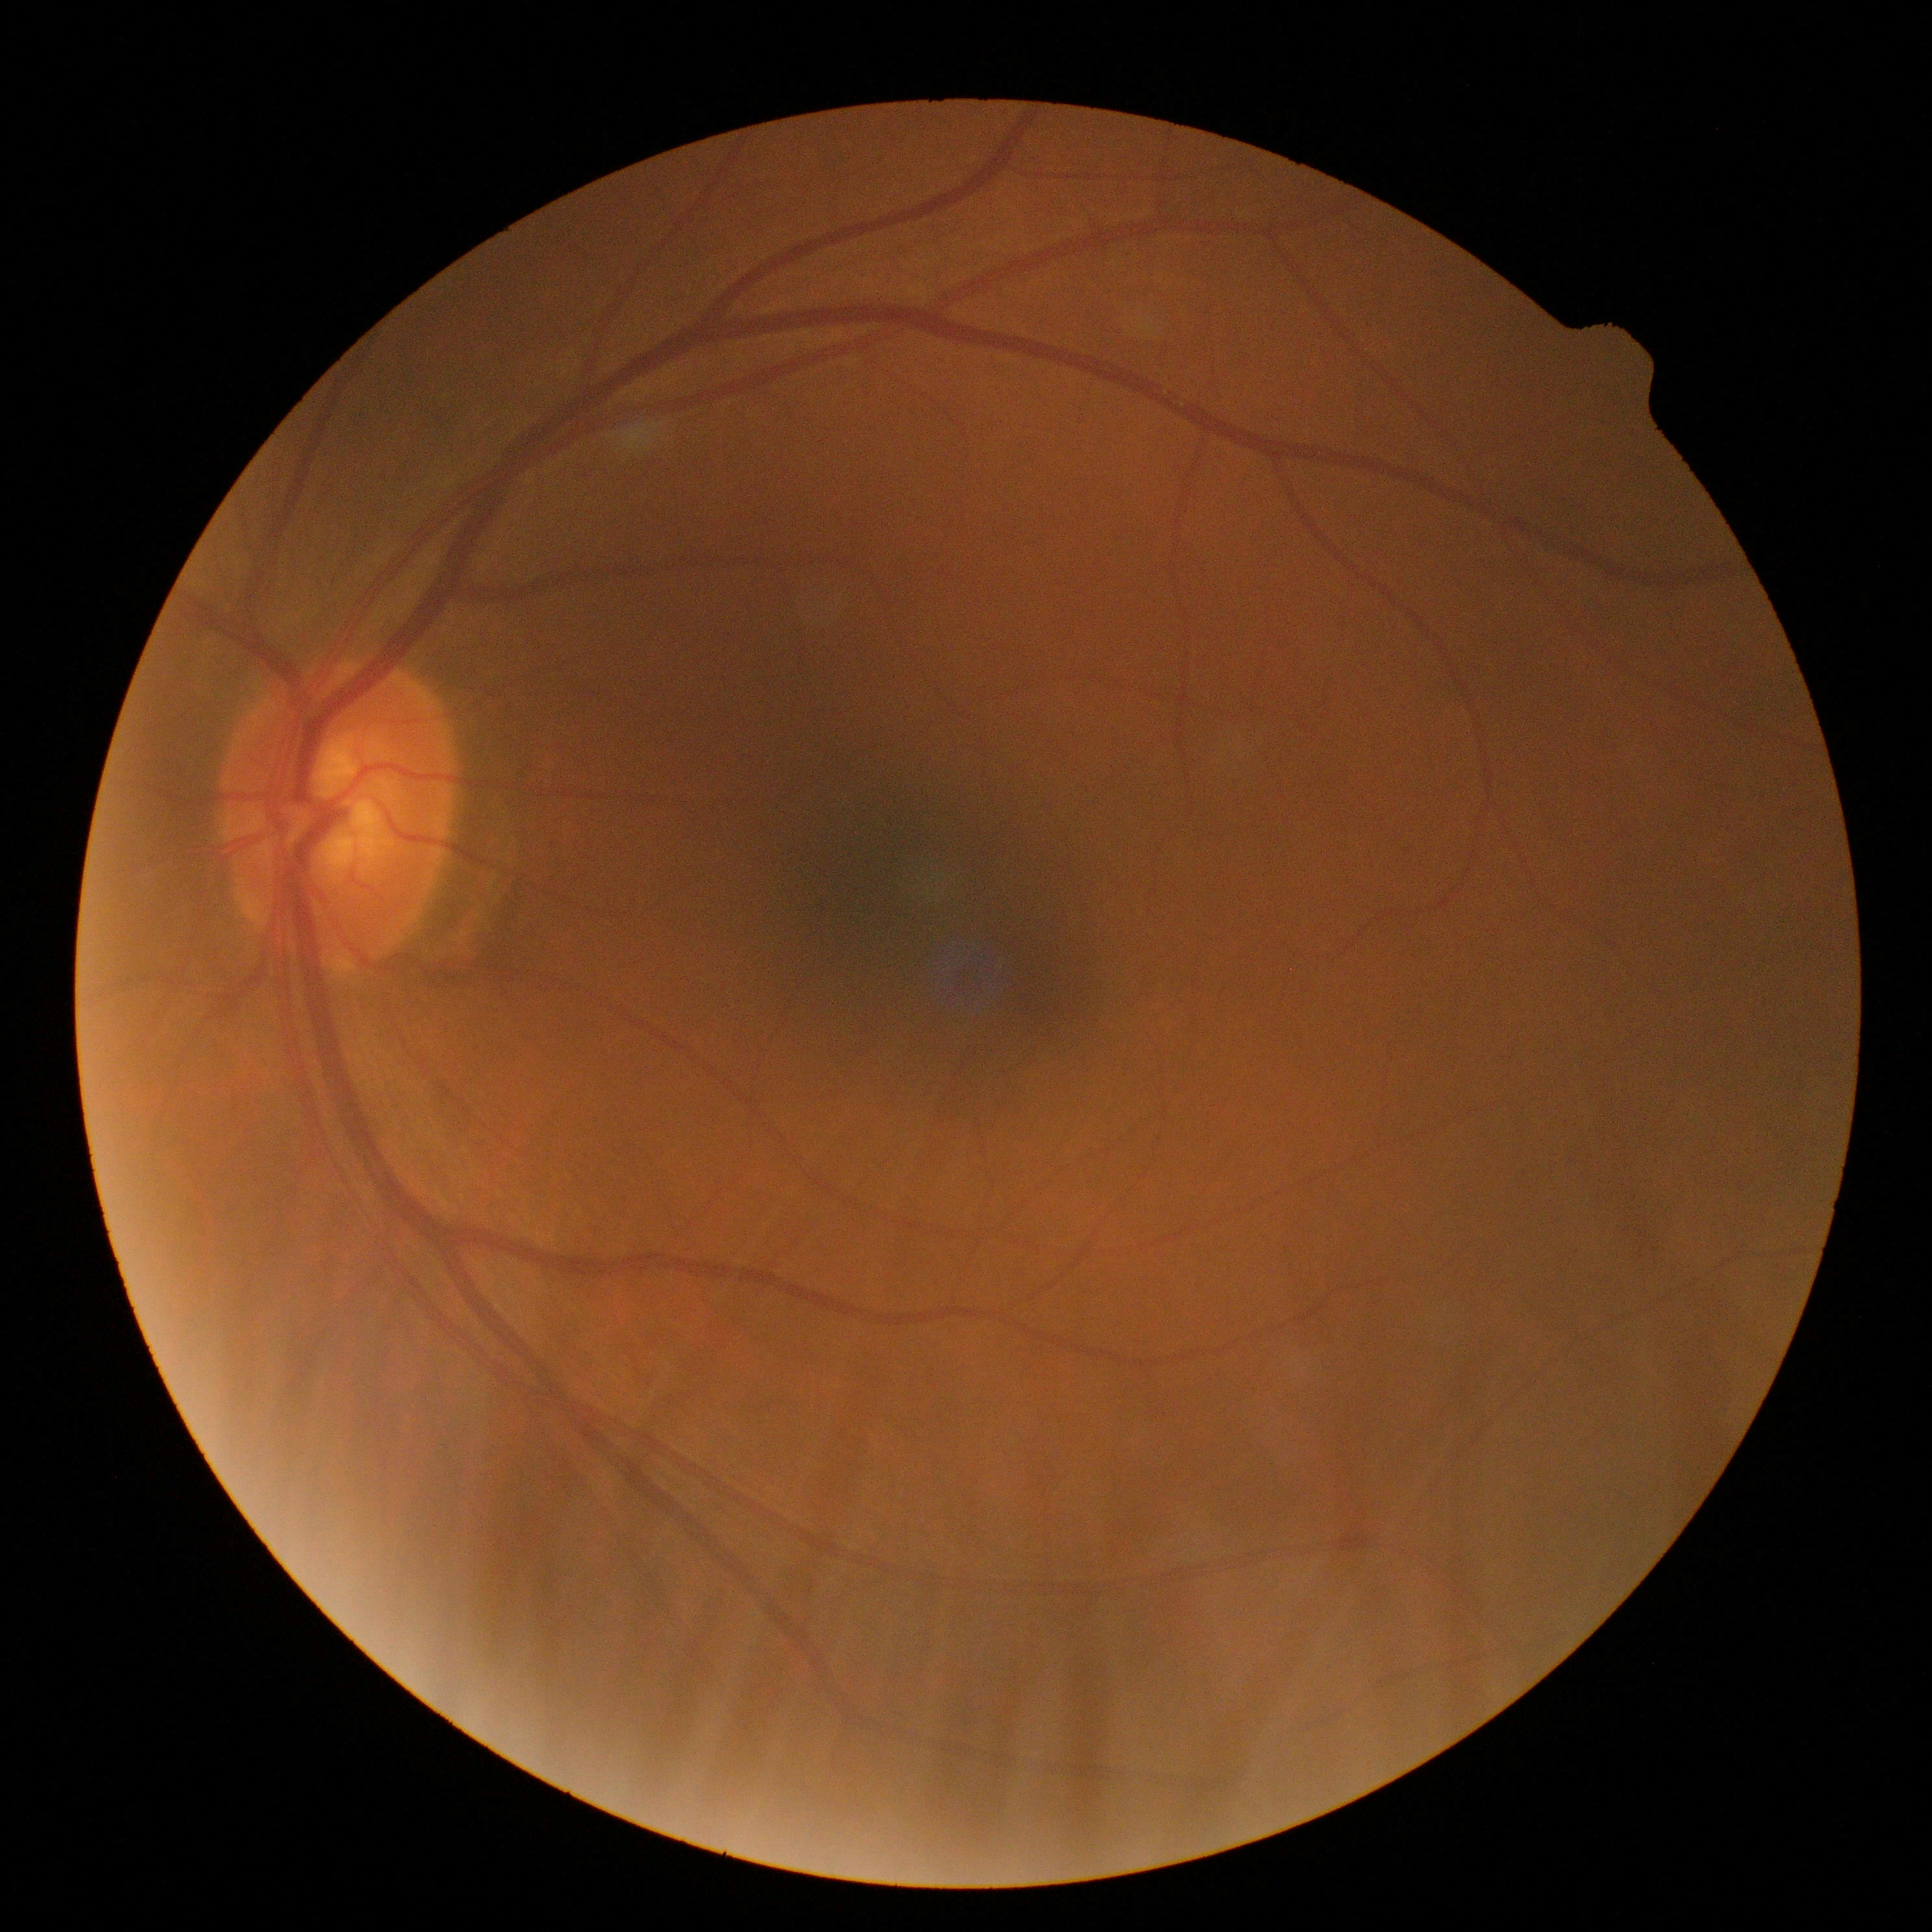
No apparent diabetic retinopathy. DR is 0.